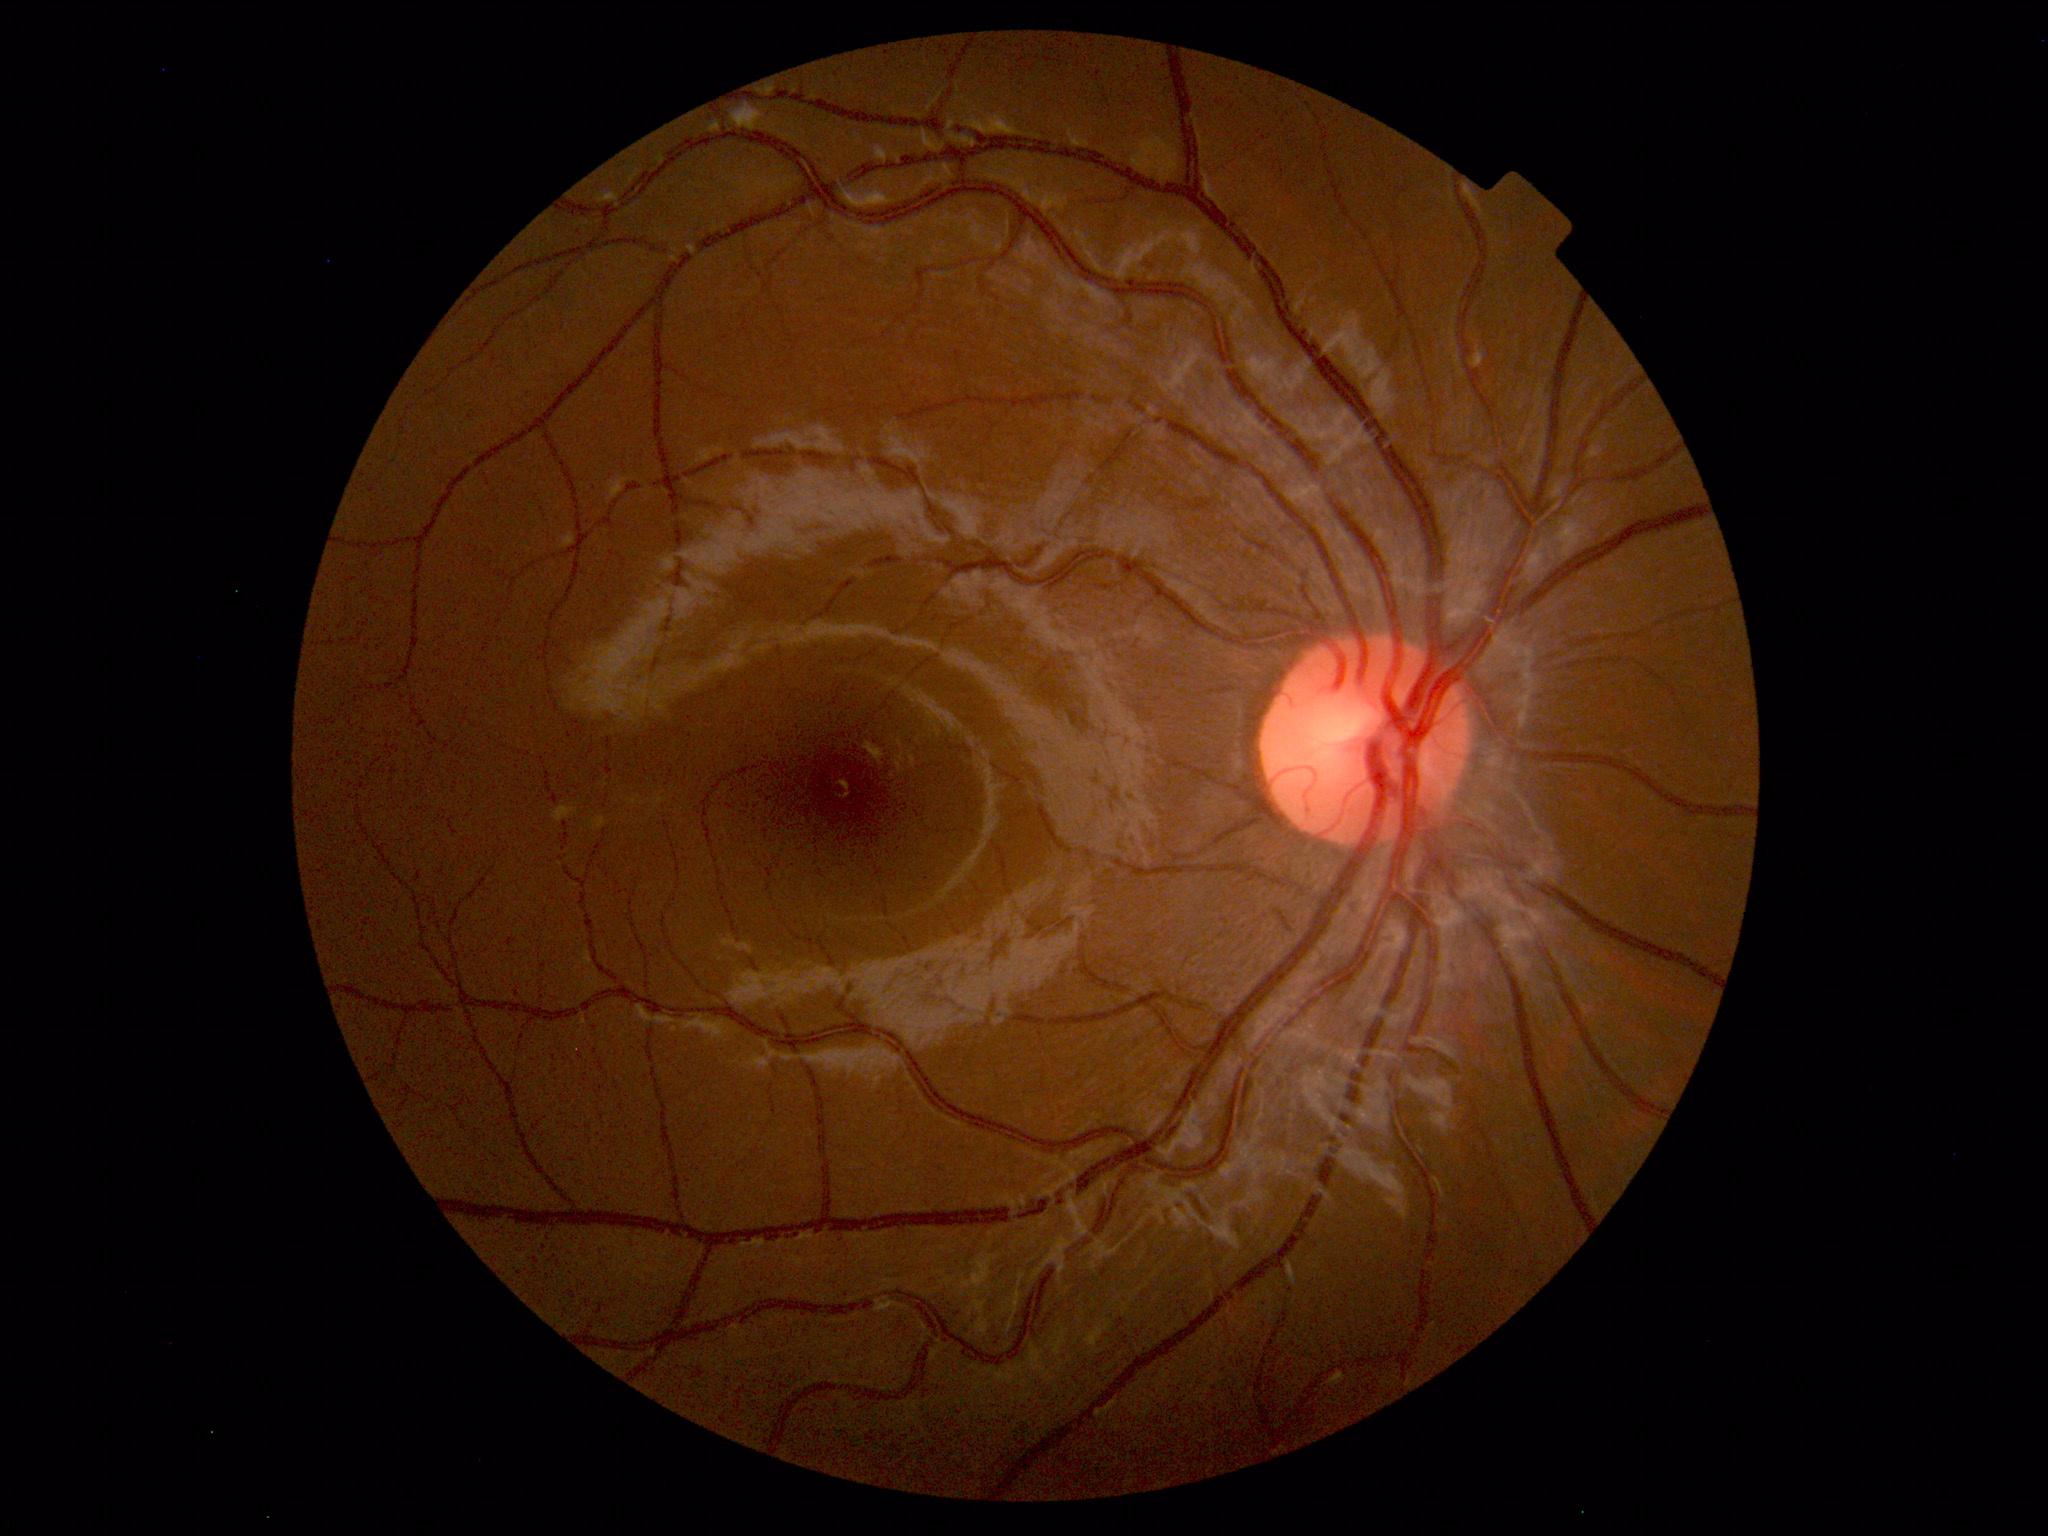

Normal fundus appearance.